640 by 480 pixels; 130° field of view (Clarity RetCam 3); wide-field fundus photograph of an infant:
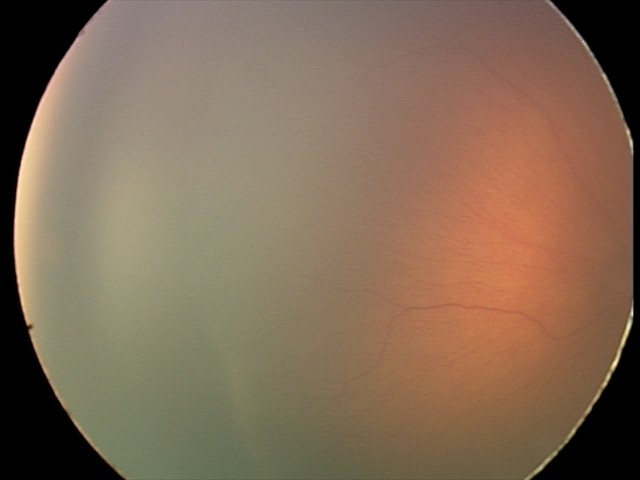
Series diagnosed as ROP stage 2 — ridge with height and width at the demarcation line. Plus disease absent.